Wide-field fundus image from infant ROP screening. 640x480px.
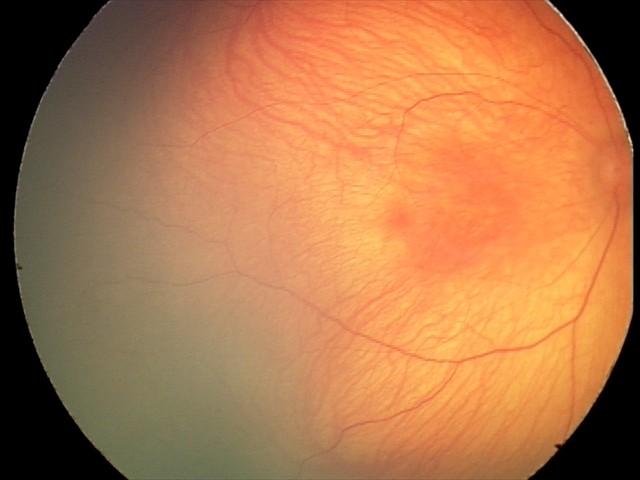

No retinal pathology identified on screening.